1240 by 1240 pixels. Pediatric retinal photograph (wide-field)
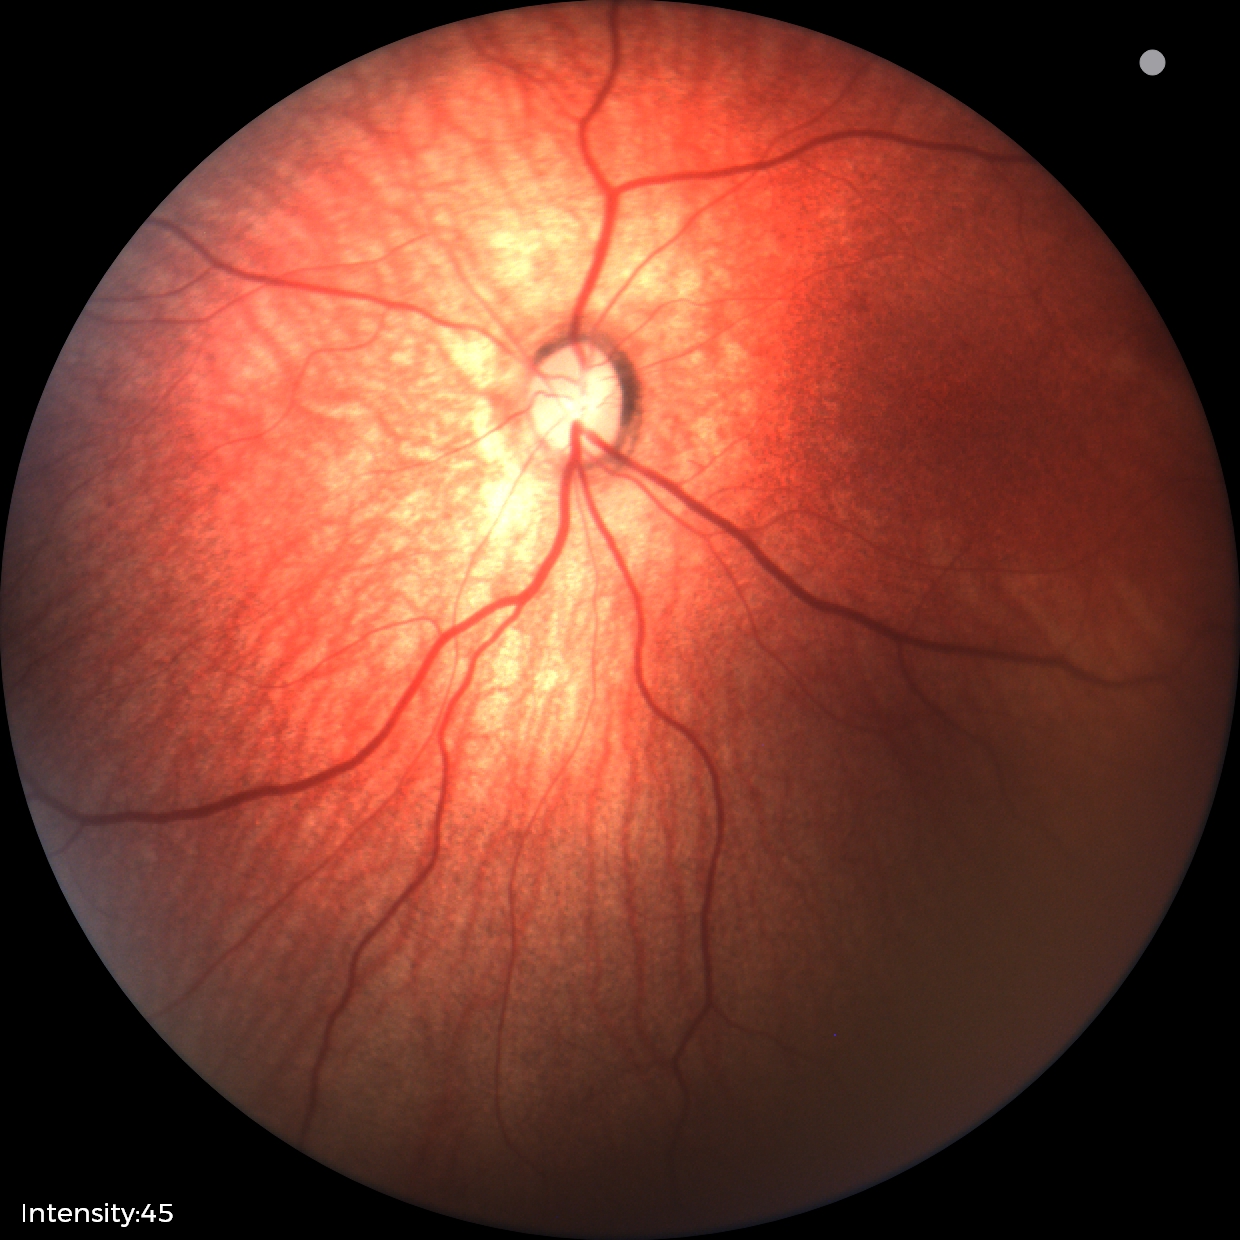

Screening examination diagnosed as physiological.